848x848px, color fundus photograph, acquired with a NIDEK AFC-230:
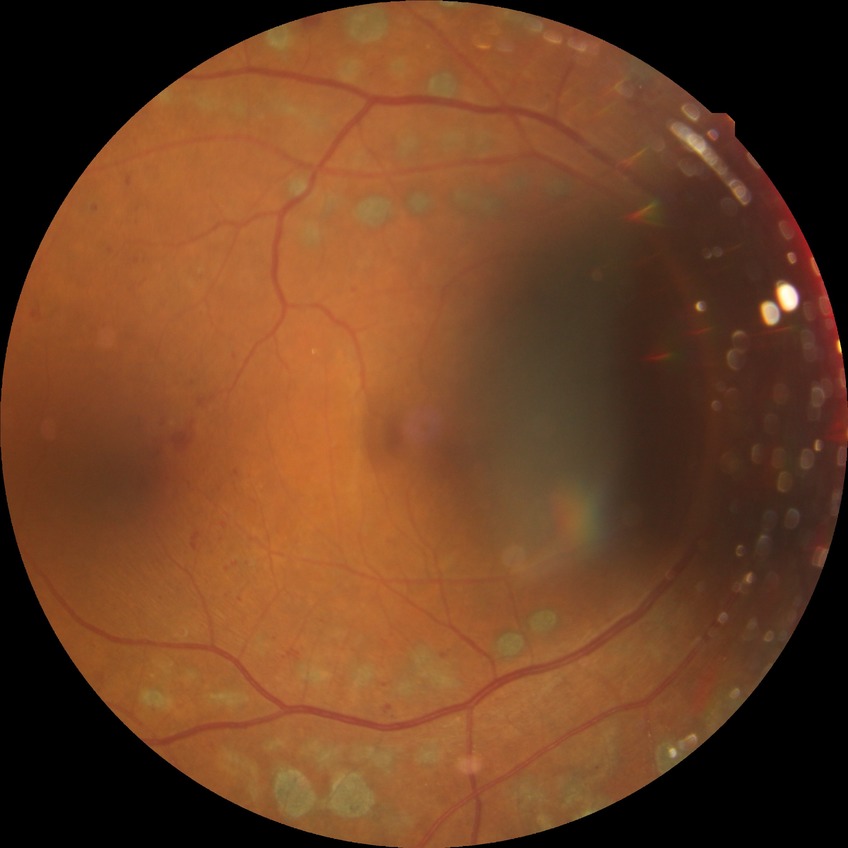
Diabetic retinopathy stage is proliferative diabetic retinopathy.